2212 by 1659 pixels · FOV: 45 degrees — 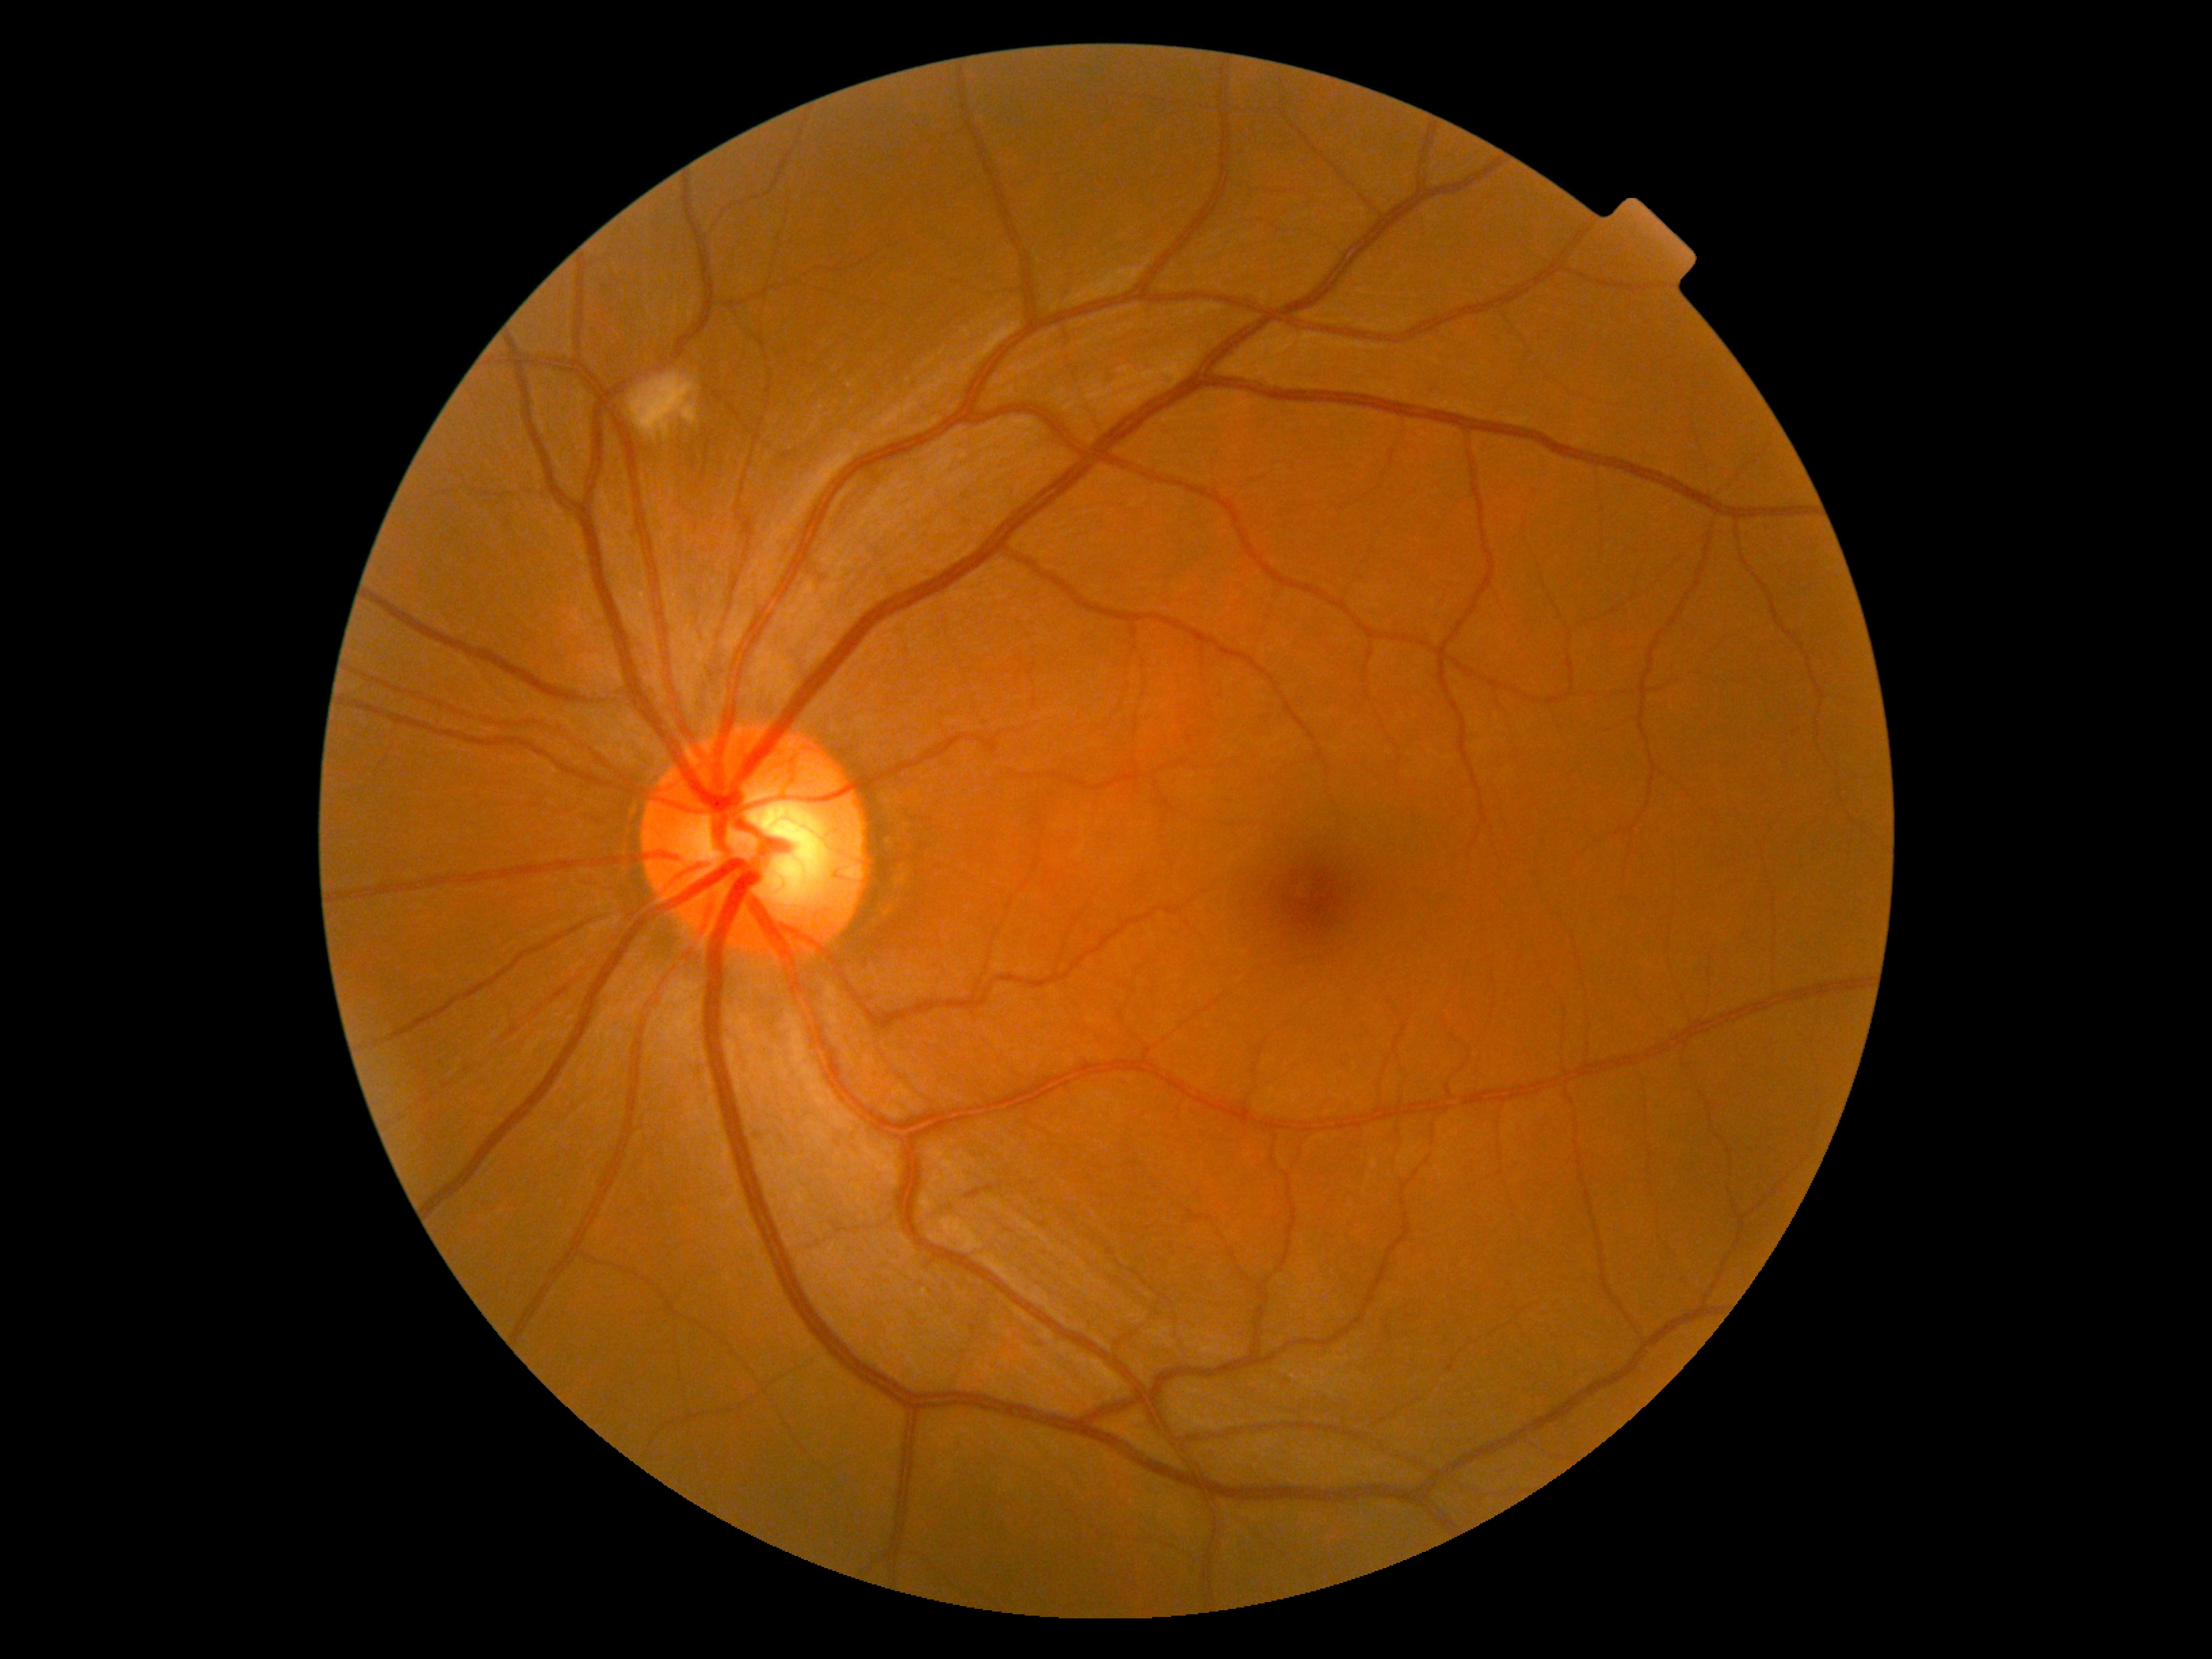
Diabetic retinopathy grade is moderate non-proliferative diabetic retinopathy (2).